Captured with the Clarity RetCam 3 (130° field of view). RetCam wide-field infant fundus image. 640 by 480 pixels — 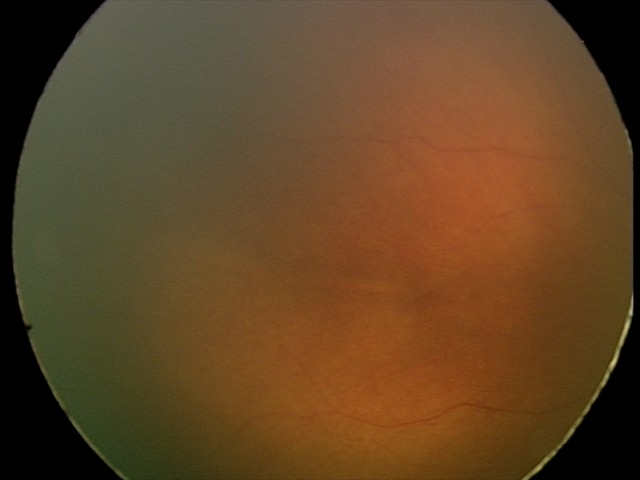 Q: What is the diagnosis from this examination?
A: physiological retinal finding